Acquired on the Natus RetCam Envision. Wide-field fundus image from infant ROP screening.
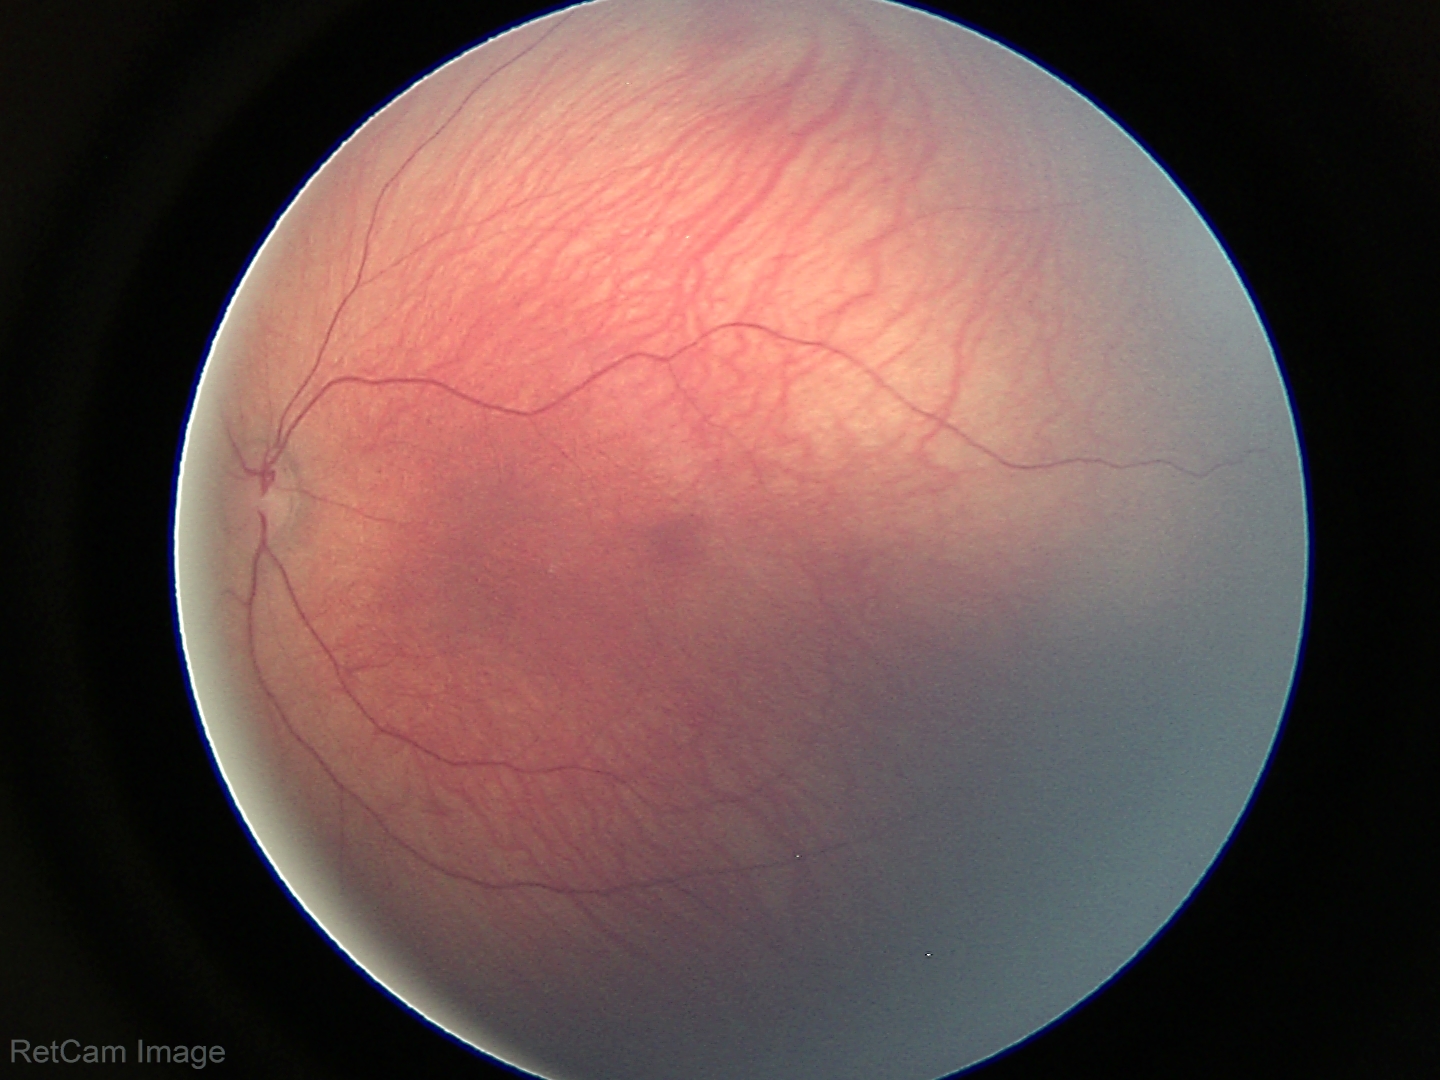
Screening examination with no abnormal retinal findings.